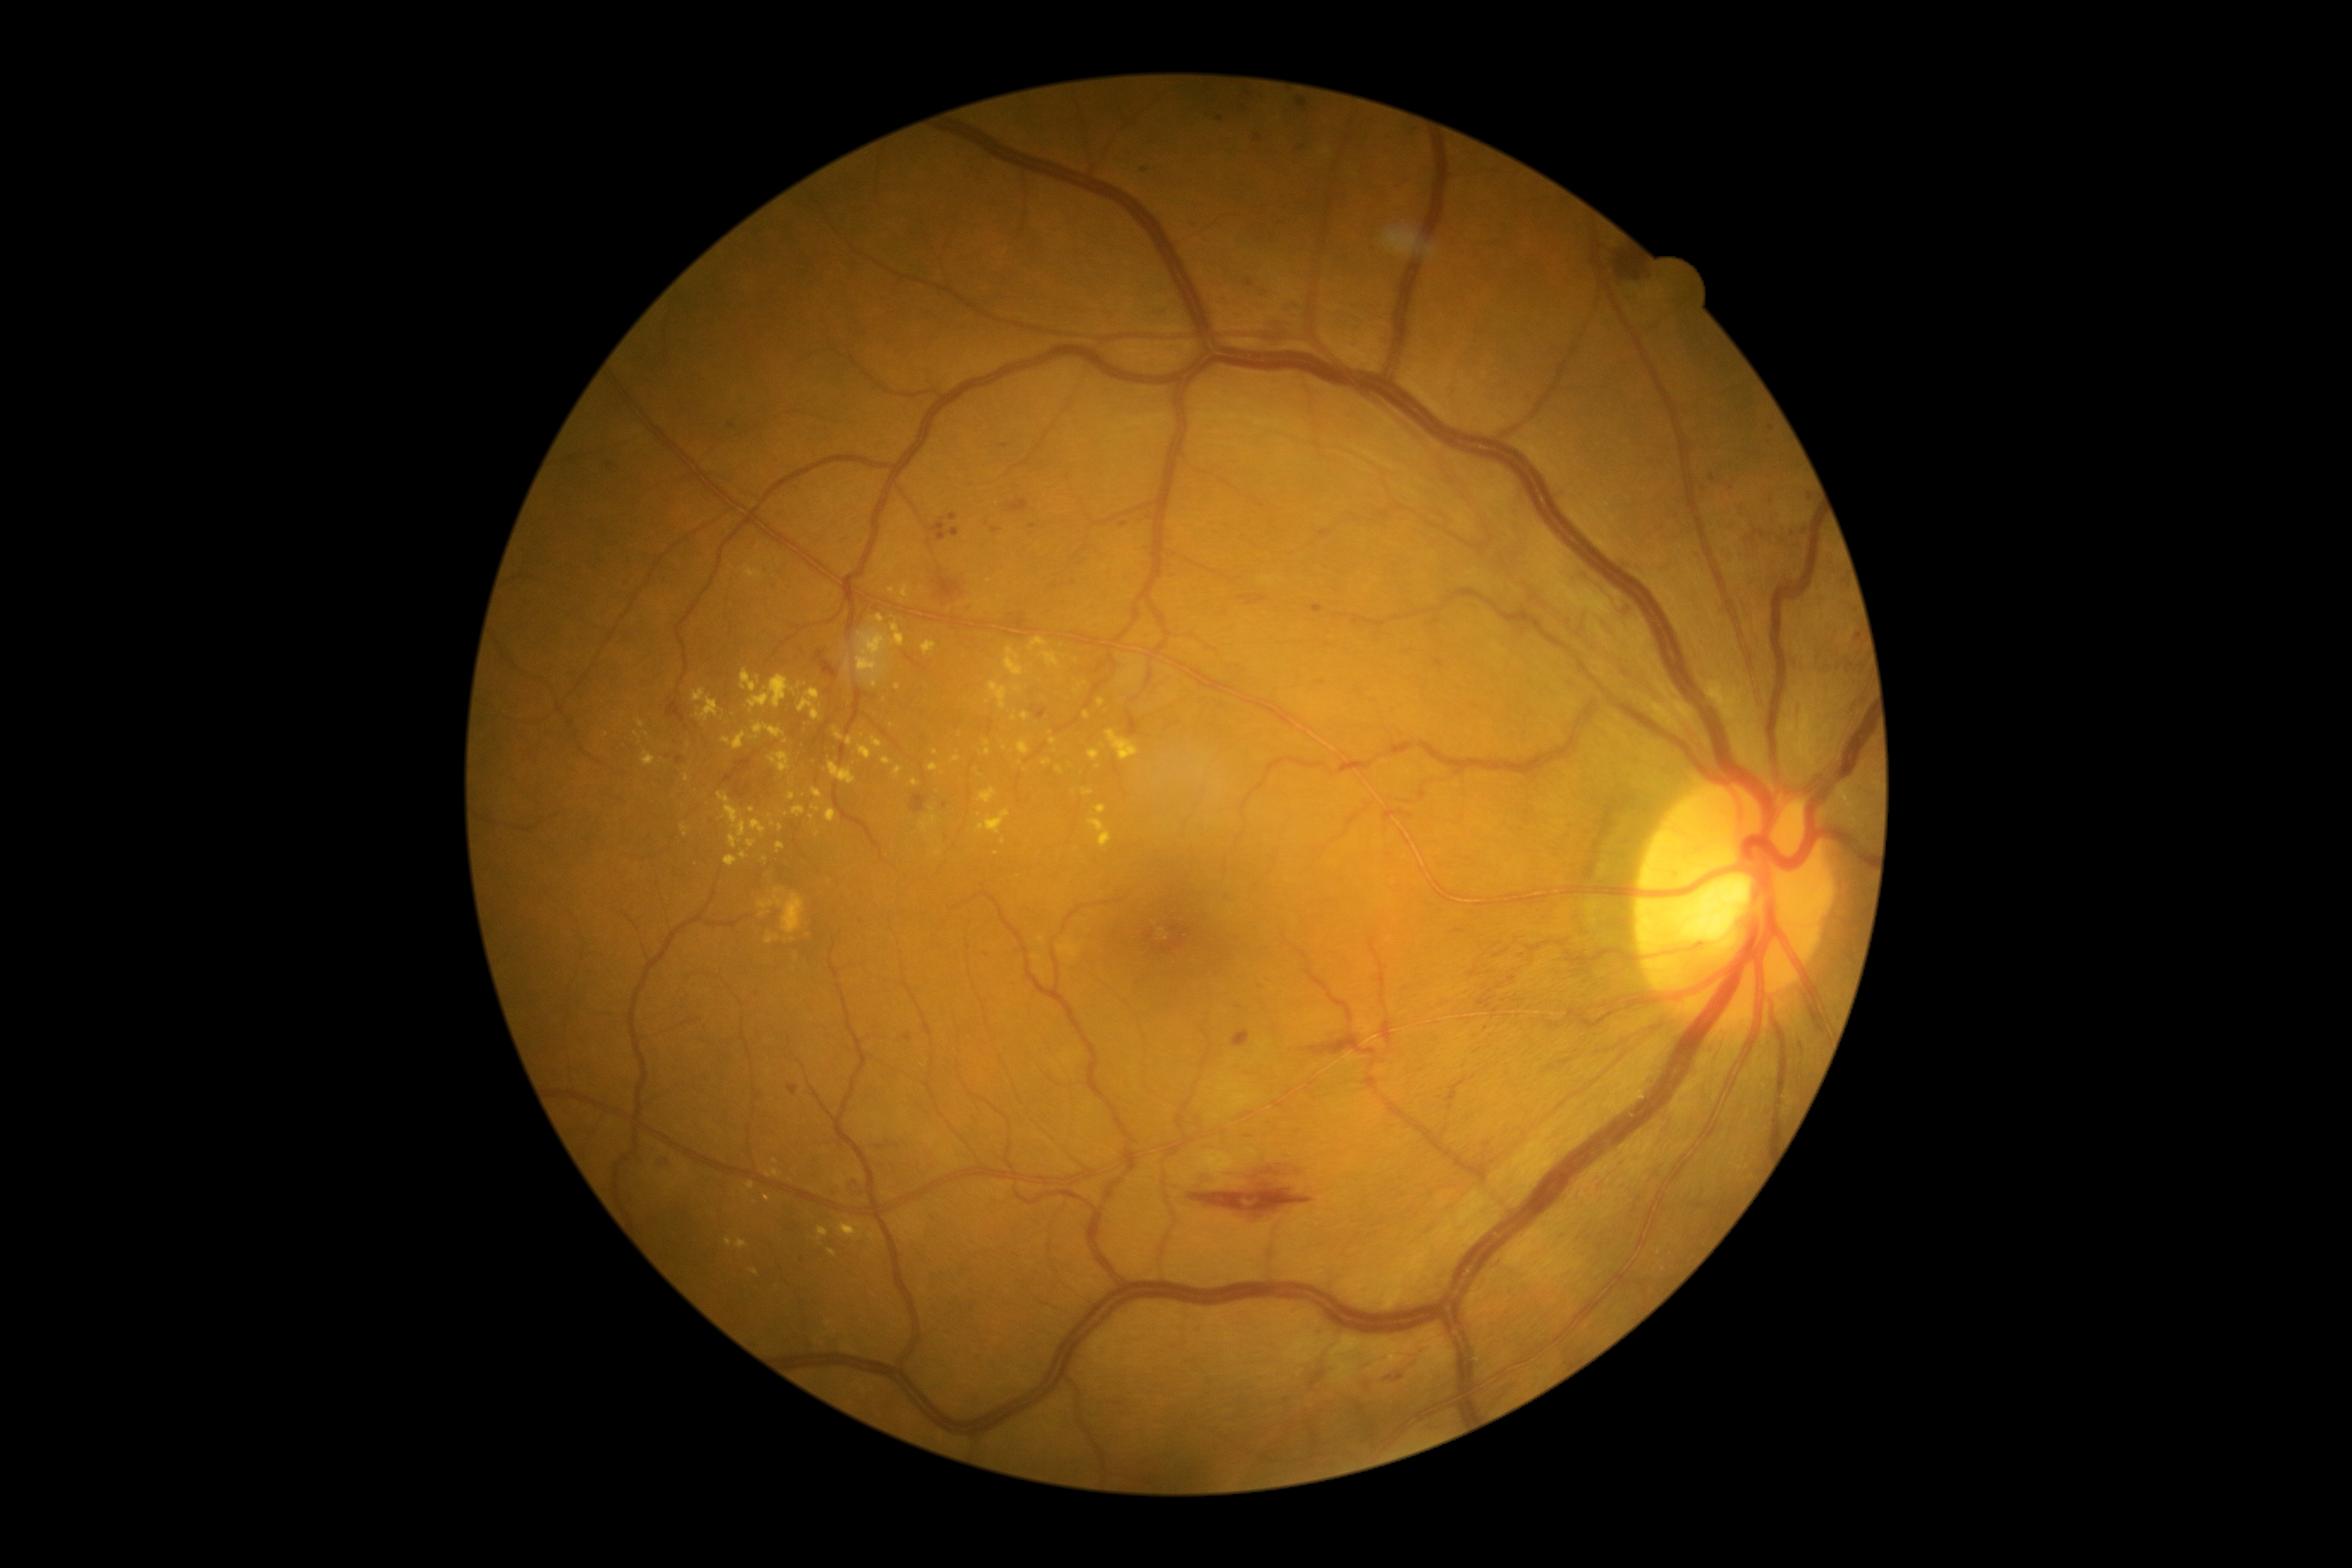
<lesions partial="true">
  <dr_grade>2</dr_grade>
  <ex partial="true">{"left": 747, "top": 840, "right": 757, "bottom": 848}; {"left": 682, "top": 824, "right": 690, "bottom": 836}; {"left": 910, "top": 780, "right": 919, "bottom": 787}; {"left": 759, "top": 890, "right": 783, "bottom": 909}; {"left": 639, "top": 720, "right": 646, "bottom": 728}; {"left": 826, "top": 809, "right": 836, "bottom": 823}; {"left": 781, "top": 893, "right": 805, "bottom": 934}; {"left": 1029, "top": 637, "right": 1048, "bottom": 651}; {"left": 683, "top": 775, "right": 689, "bottom": 783}; {"left": 830, "top": 763, "right": 857, "bottom": 785}; {"left": 745, "top": 568, "right": 763, "bottom": 579}; {"left": 1020, "top": 713, "right": 1029, "bottom": 721}</ex>
  <ex_small_centers>(836, 594); (1014, 718); (765, 859); (799, 686); (892, 590); (743, 855); (1077, 692)</ex_small_centers>
</lesions>